Modified Davis classification · camera: NIDEK AFC-230 · 848 x 848 pixels — 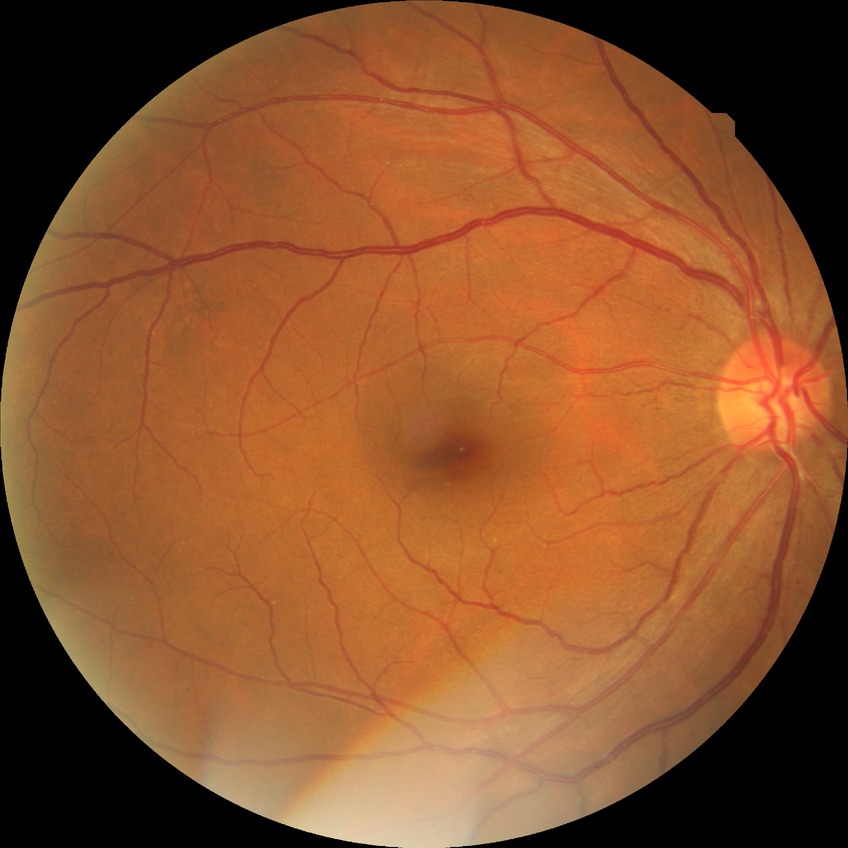 Diabetic retinopathy severity is no diabetic retinopathy.